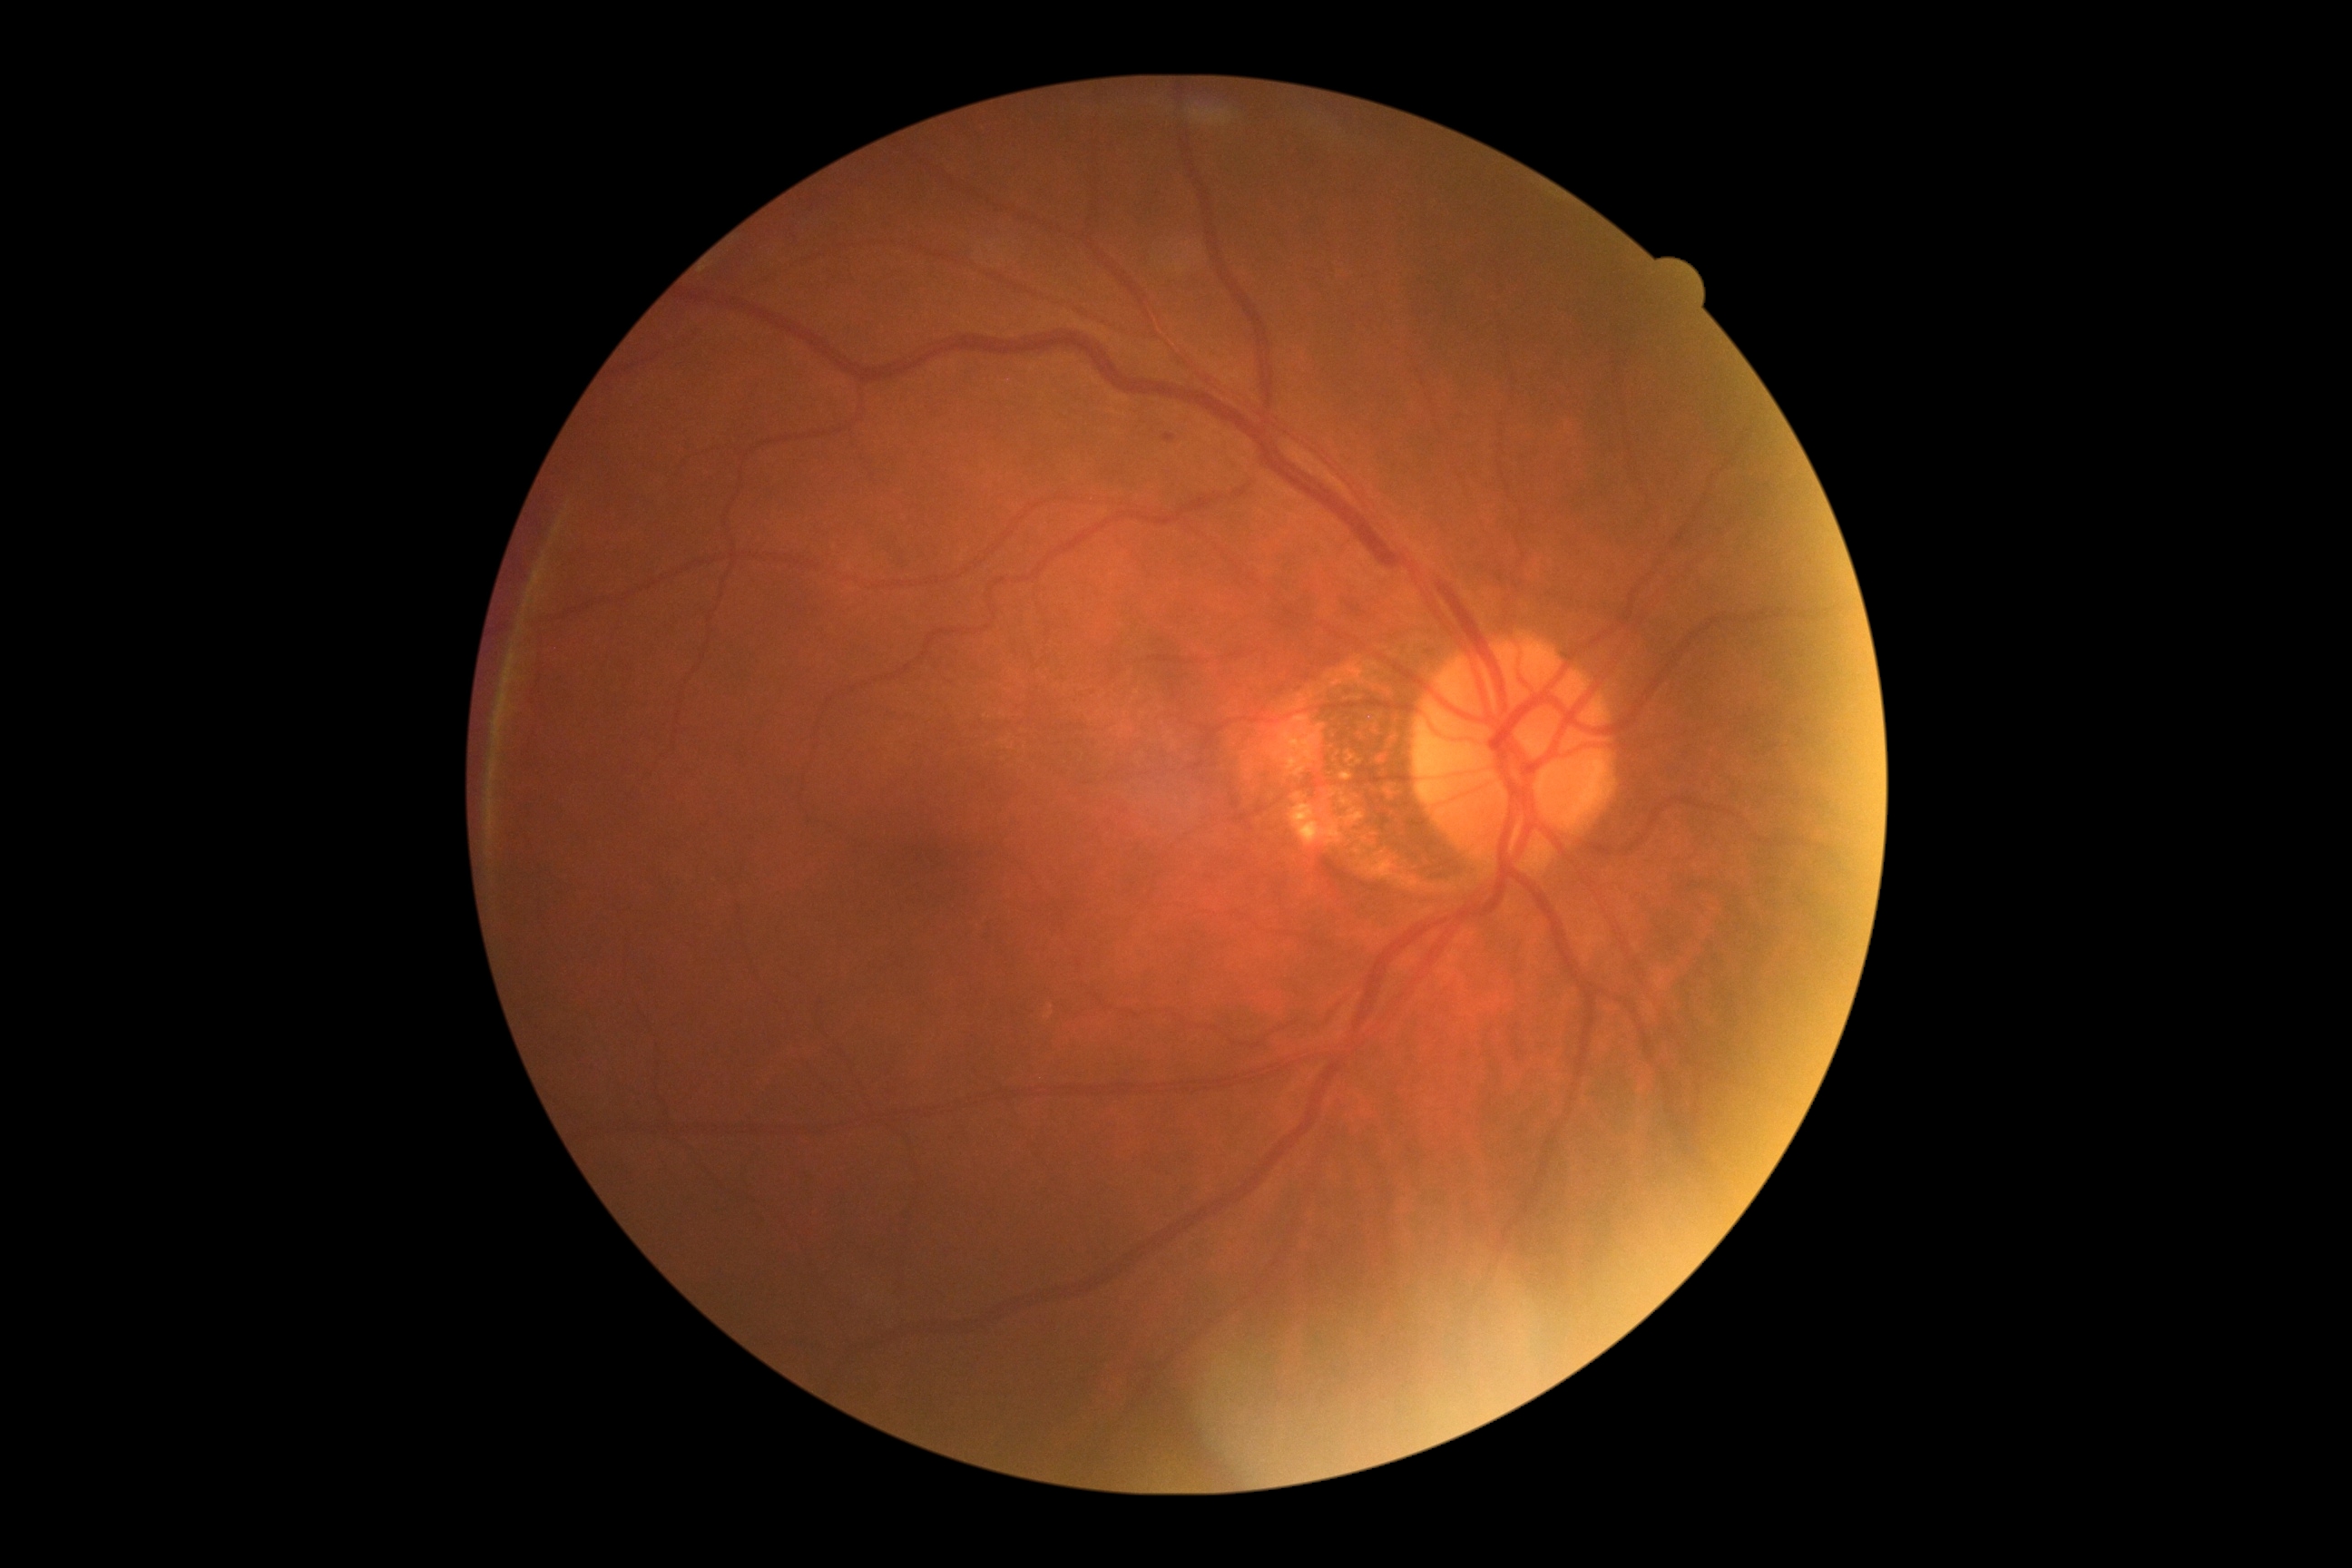
retinopathy grade: 1
DR class: non-proliferative diabetic retinopathy